2228x1652px · dilated-pupil acquisition
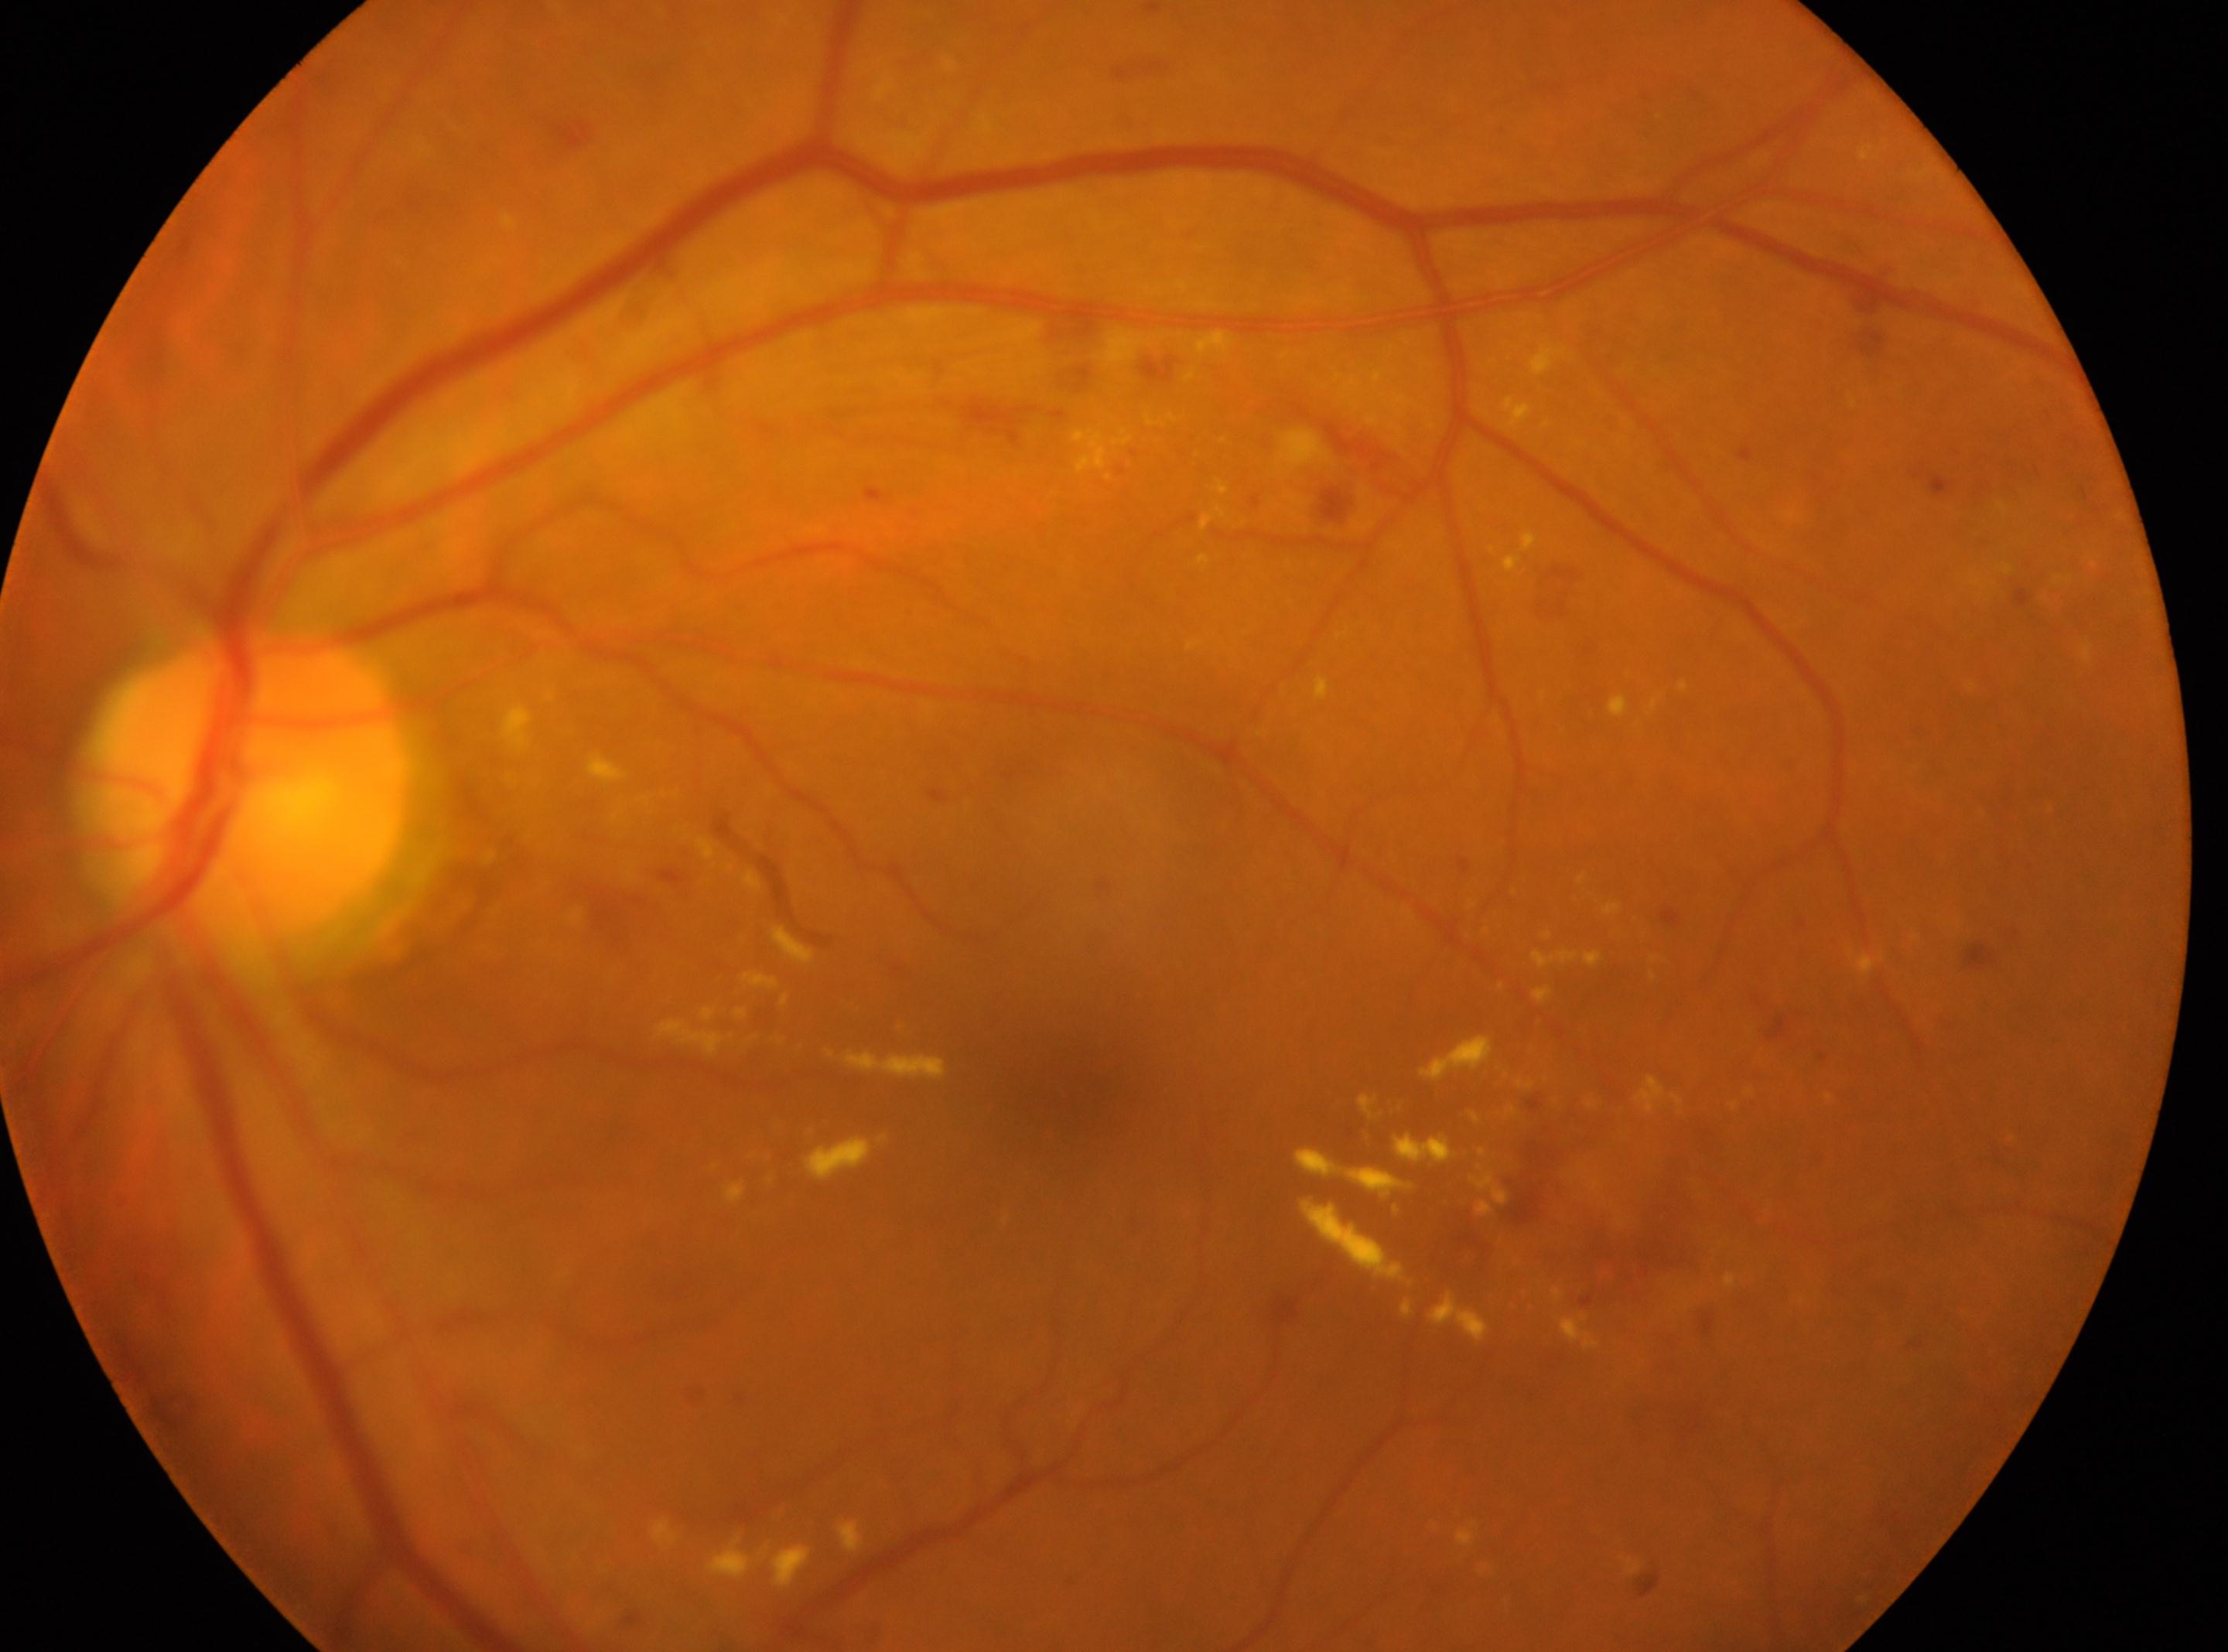
• macular center · [1063, 1081]
• laterality · the left eye
• optic nerve head · [252, 787]
• DR class · non-proliferative diabetic retinopathy
• DR grade · 2 (moderate NPDR)